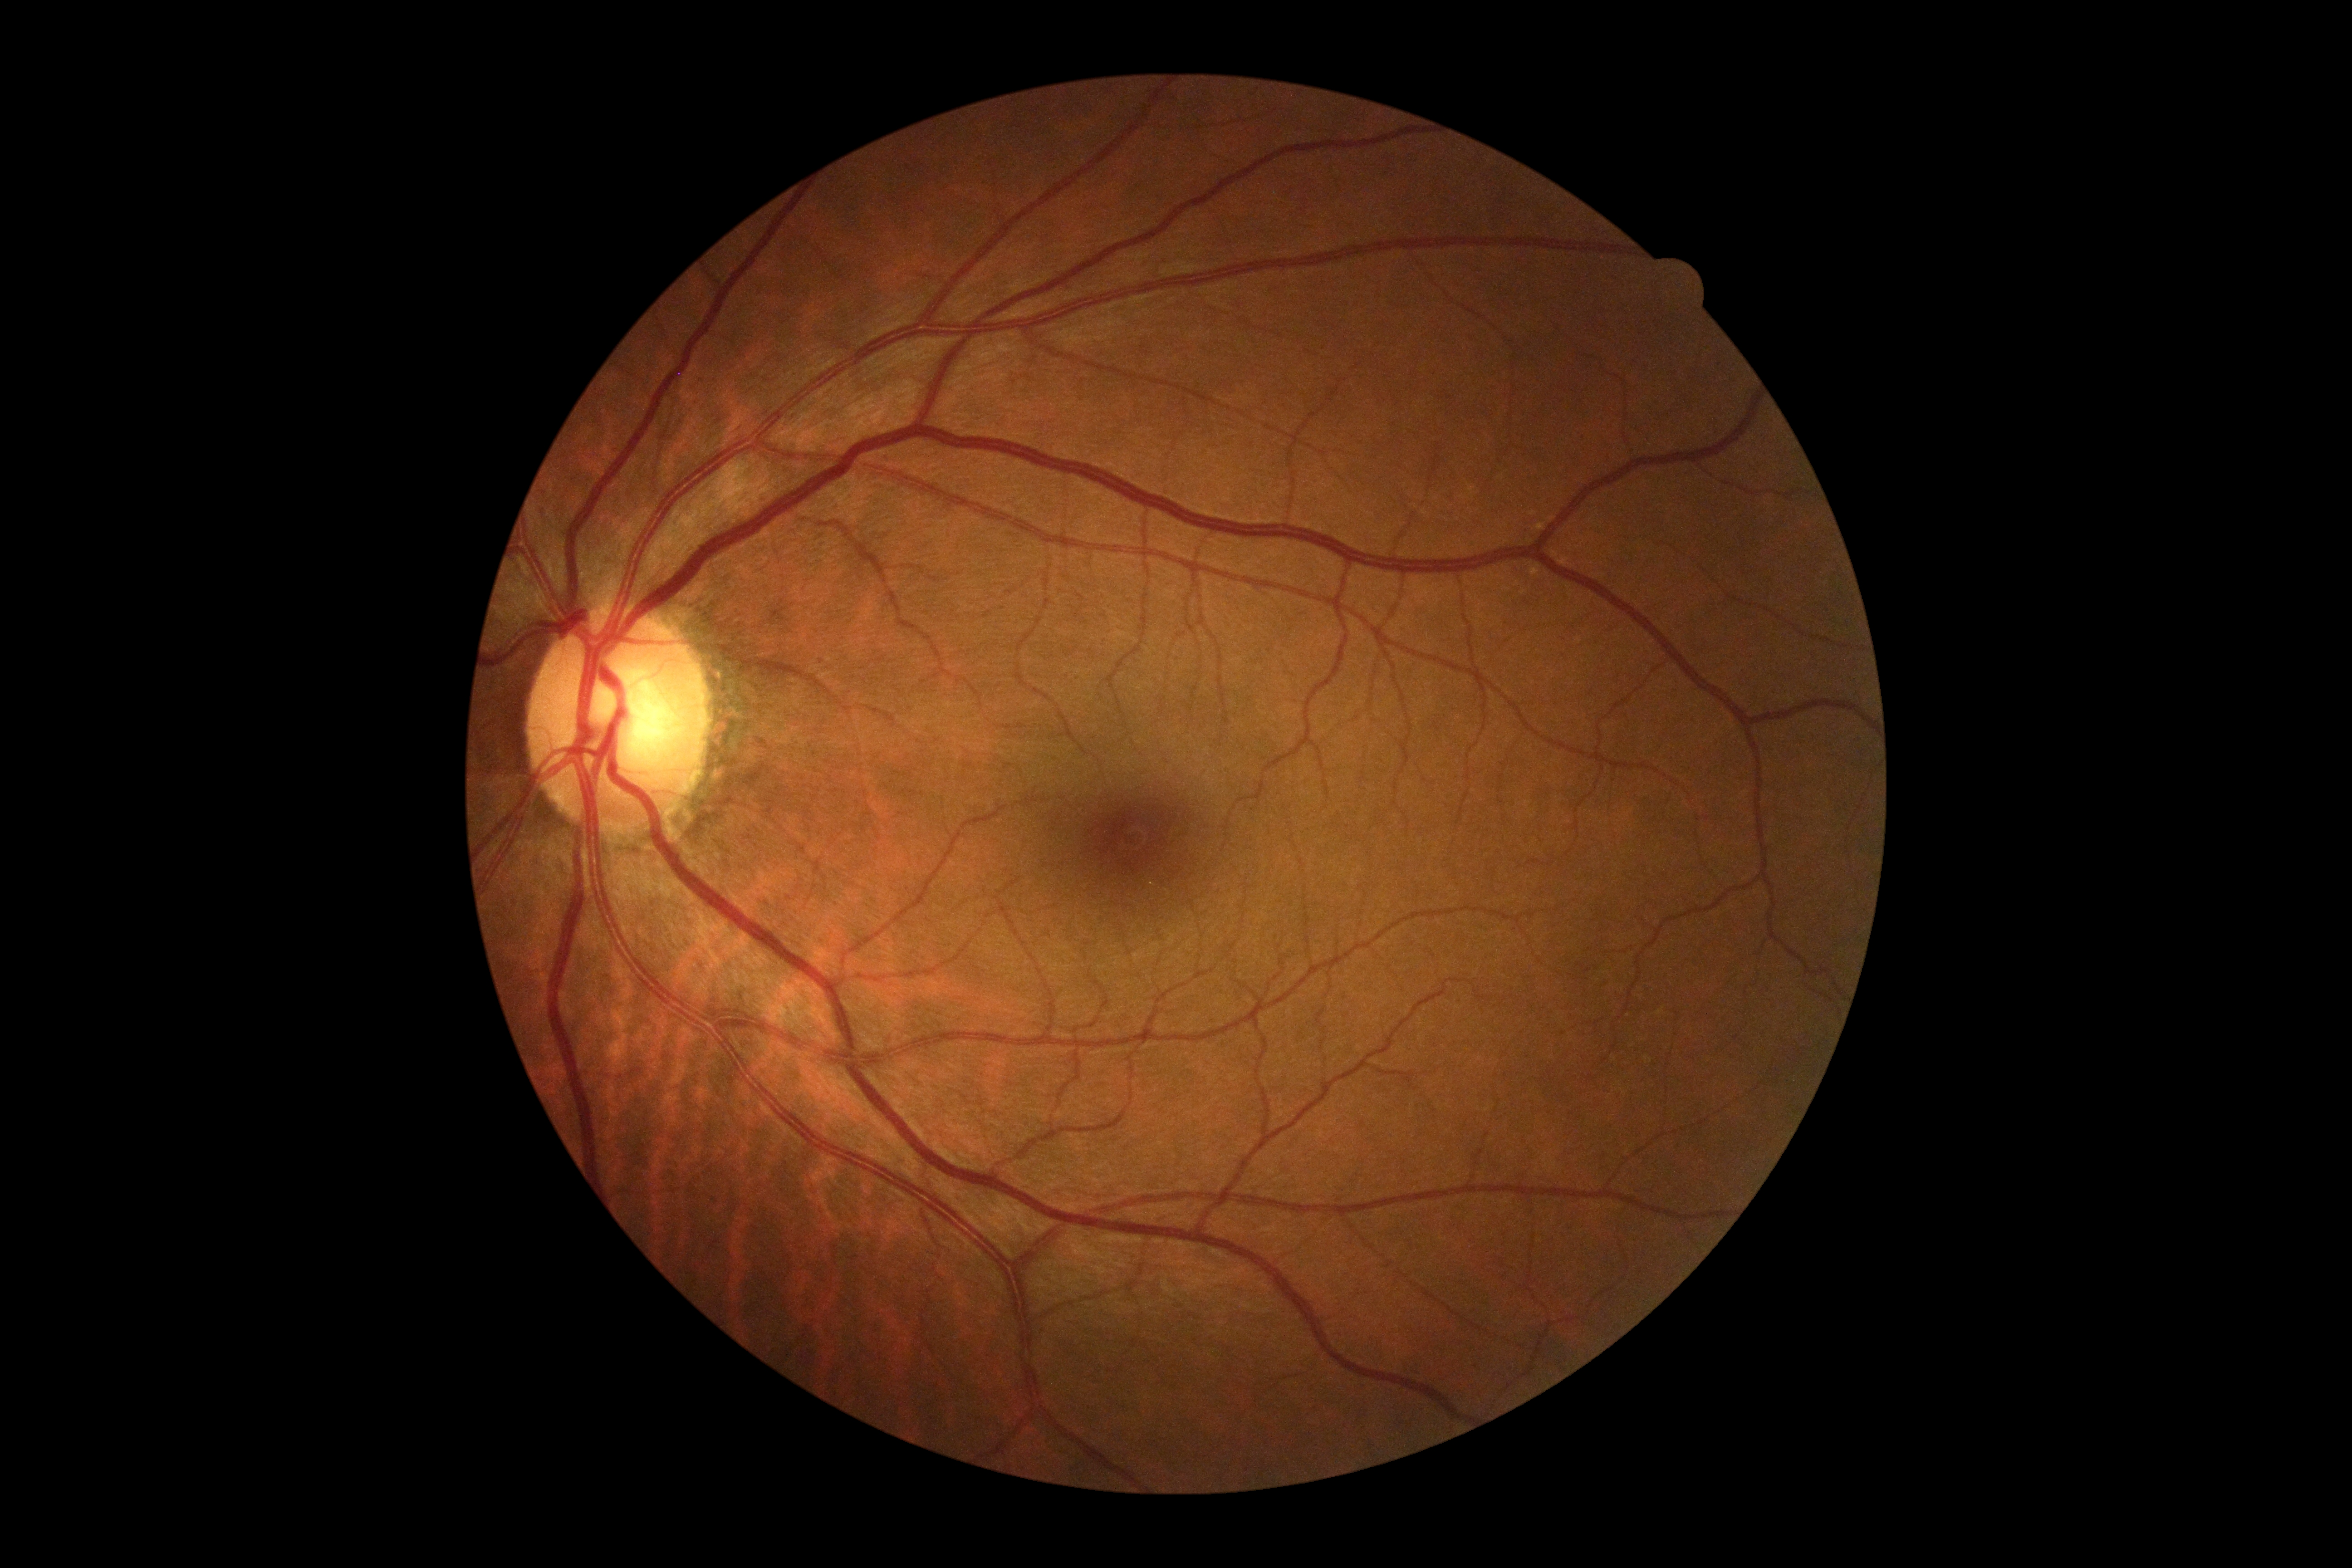 DR=no apparent diabetic retinopathy (grade 0) — no visible signs of diabetic retinopathy.